Nonmydriatic.
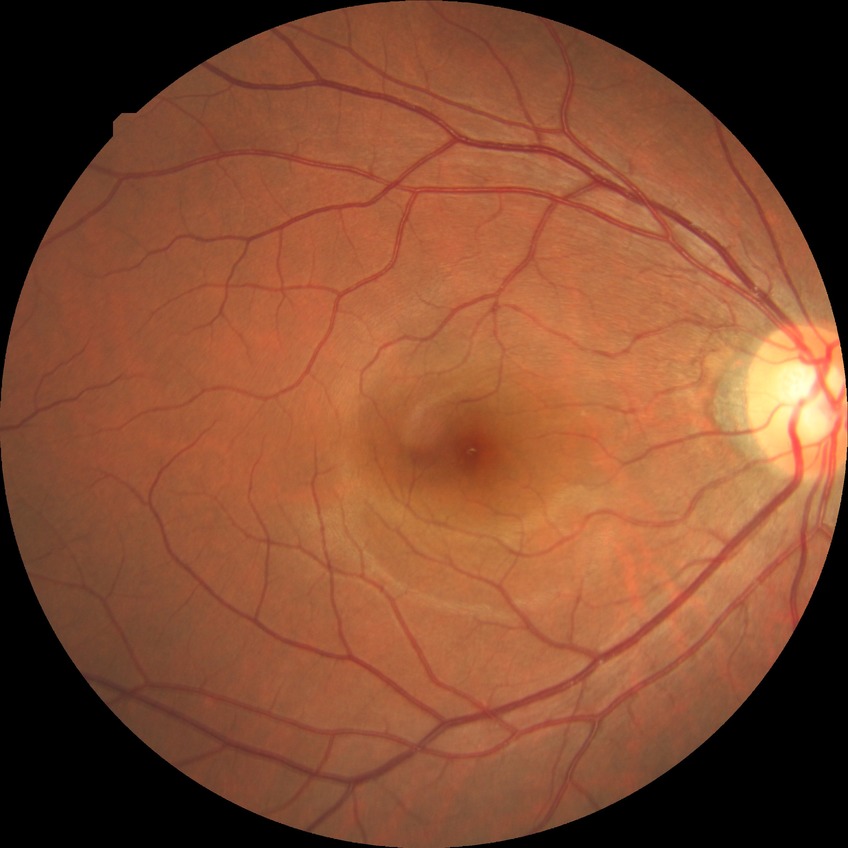
Diabetic retinopathy (DR): NDR (no diabetic retinopathy).